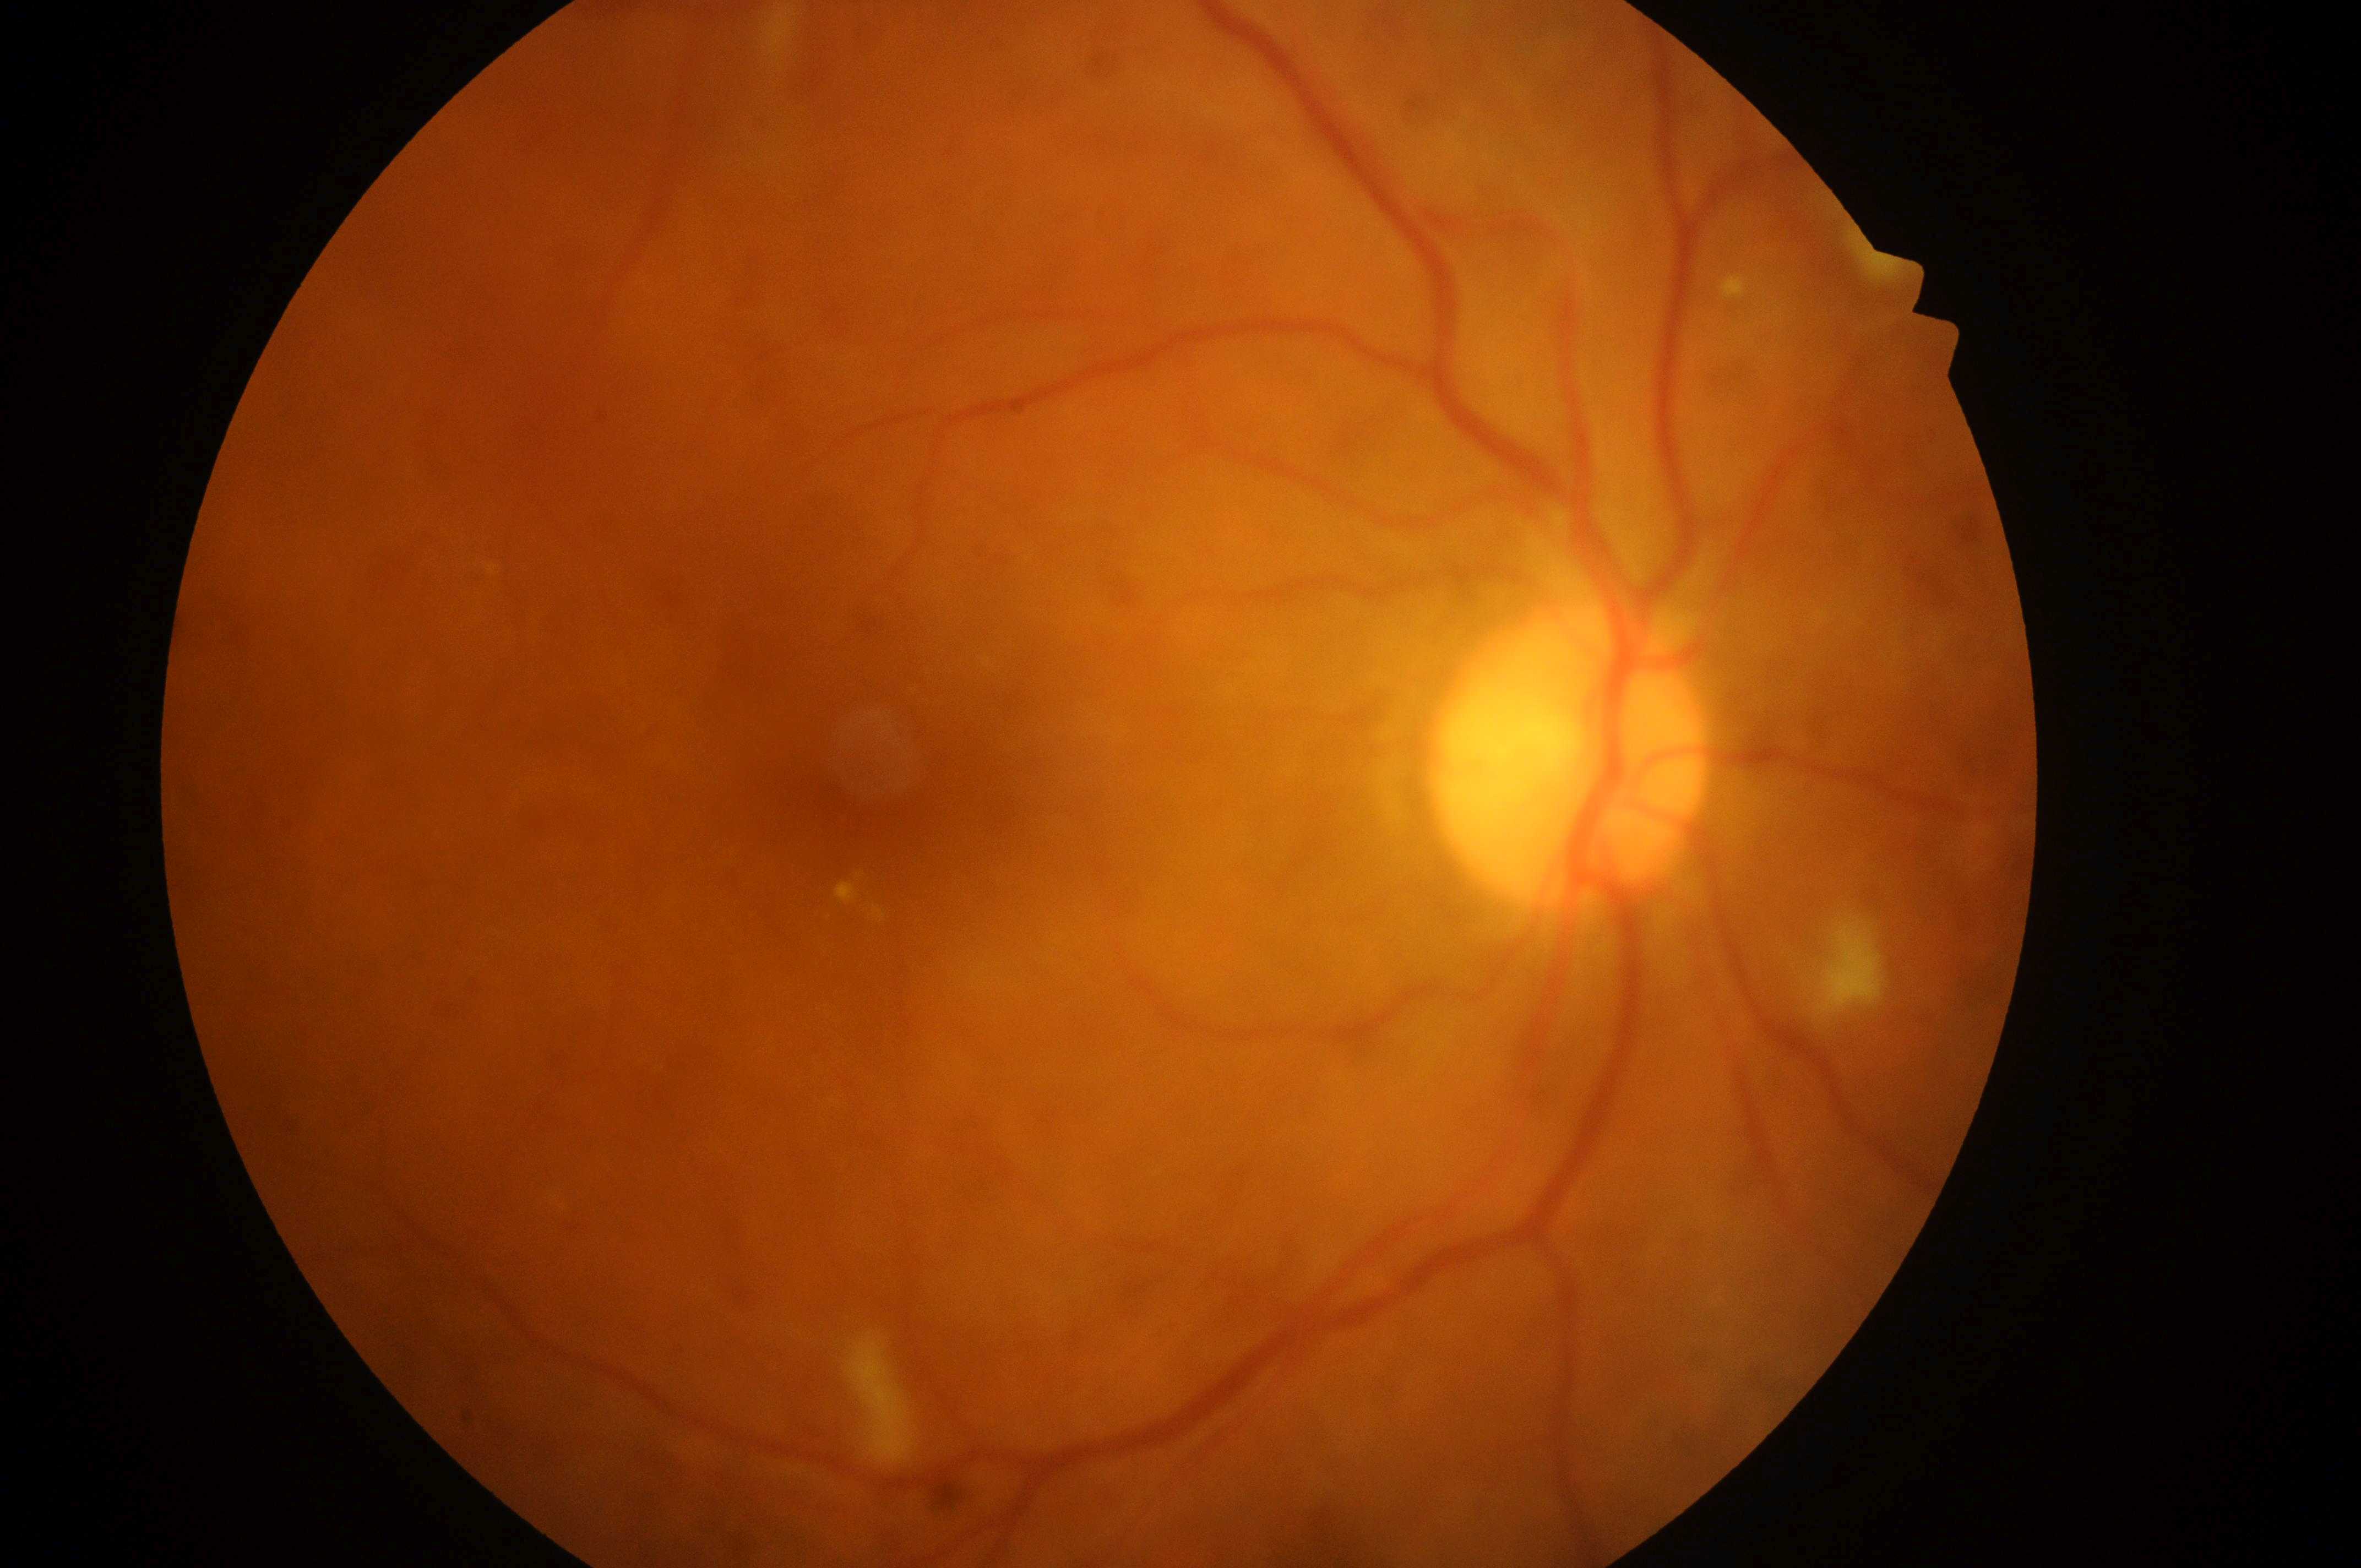
Diabetic macular edema (DME): grade 2 (high risk). Disc center located at x=1572, y=775. The fovea is at x=879, y=798. This is the right eye. Diabetic retinopathy (DR): grade 2 (moderate NPDR).